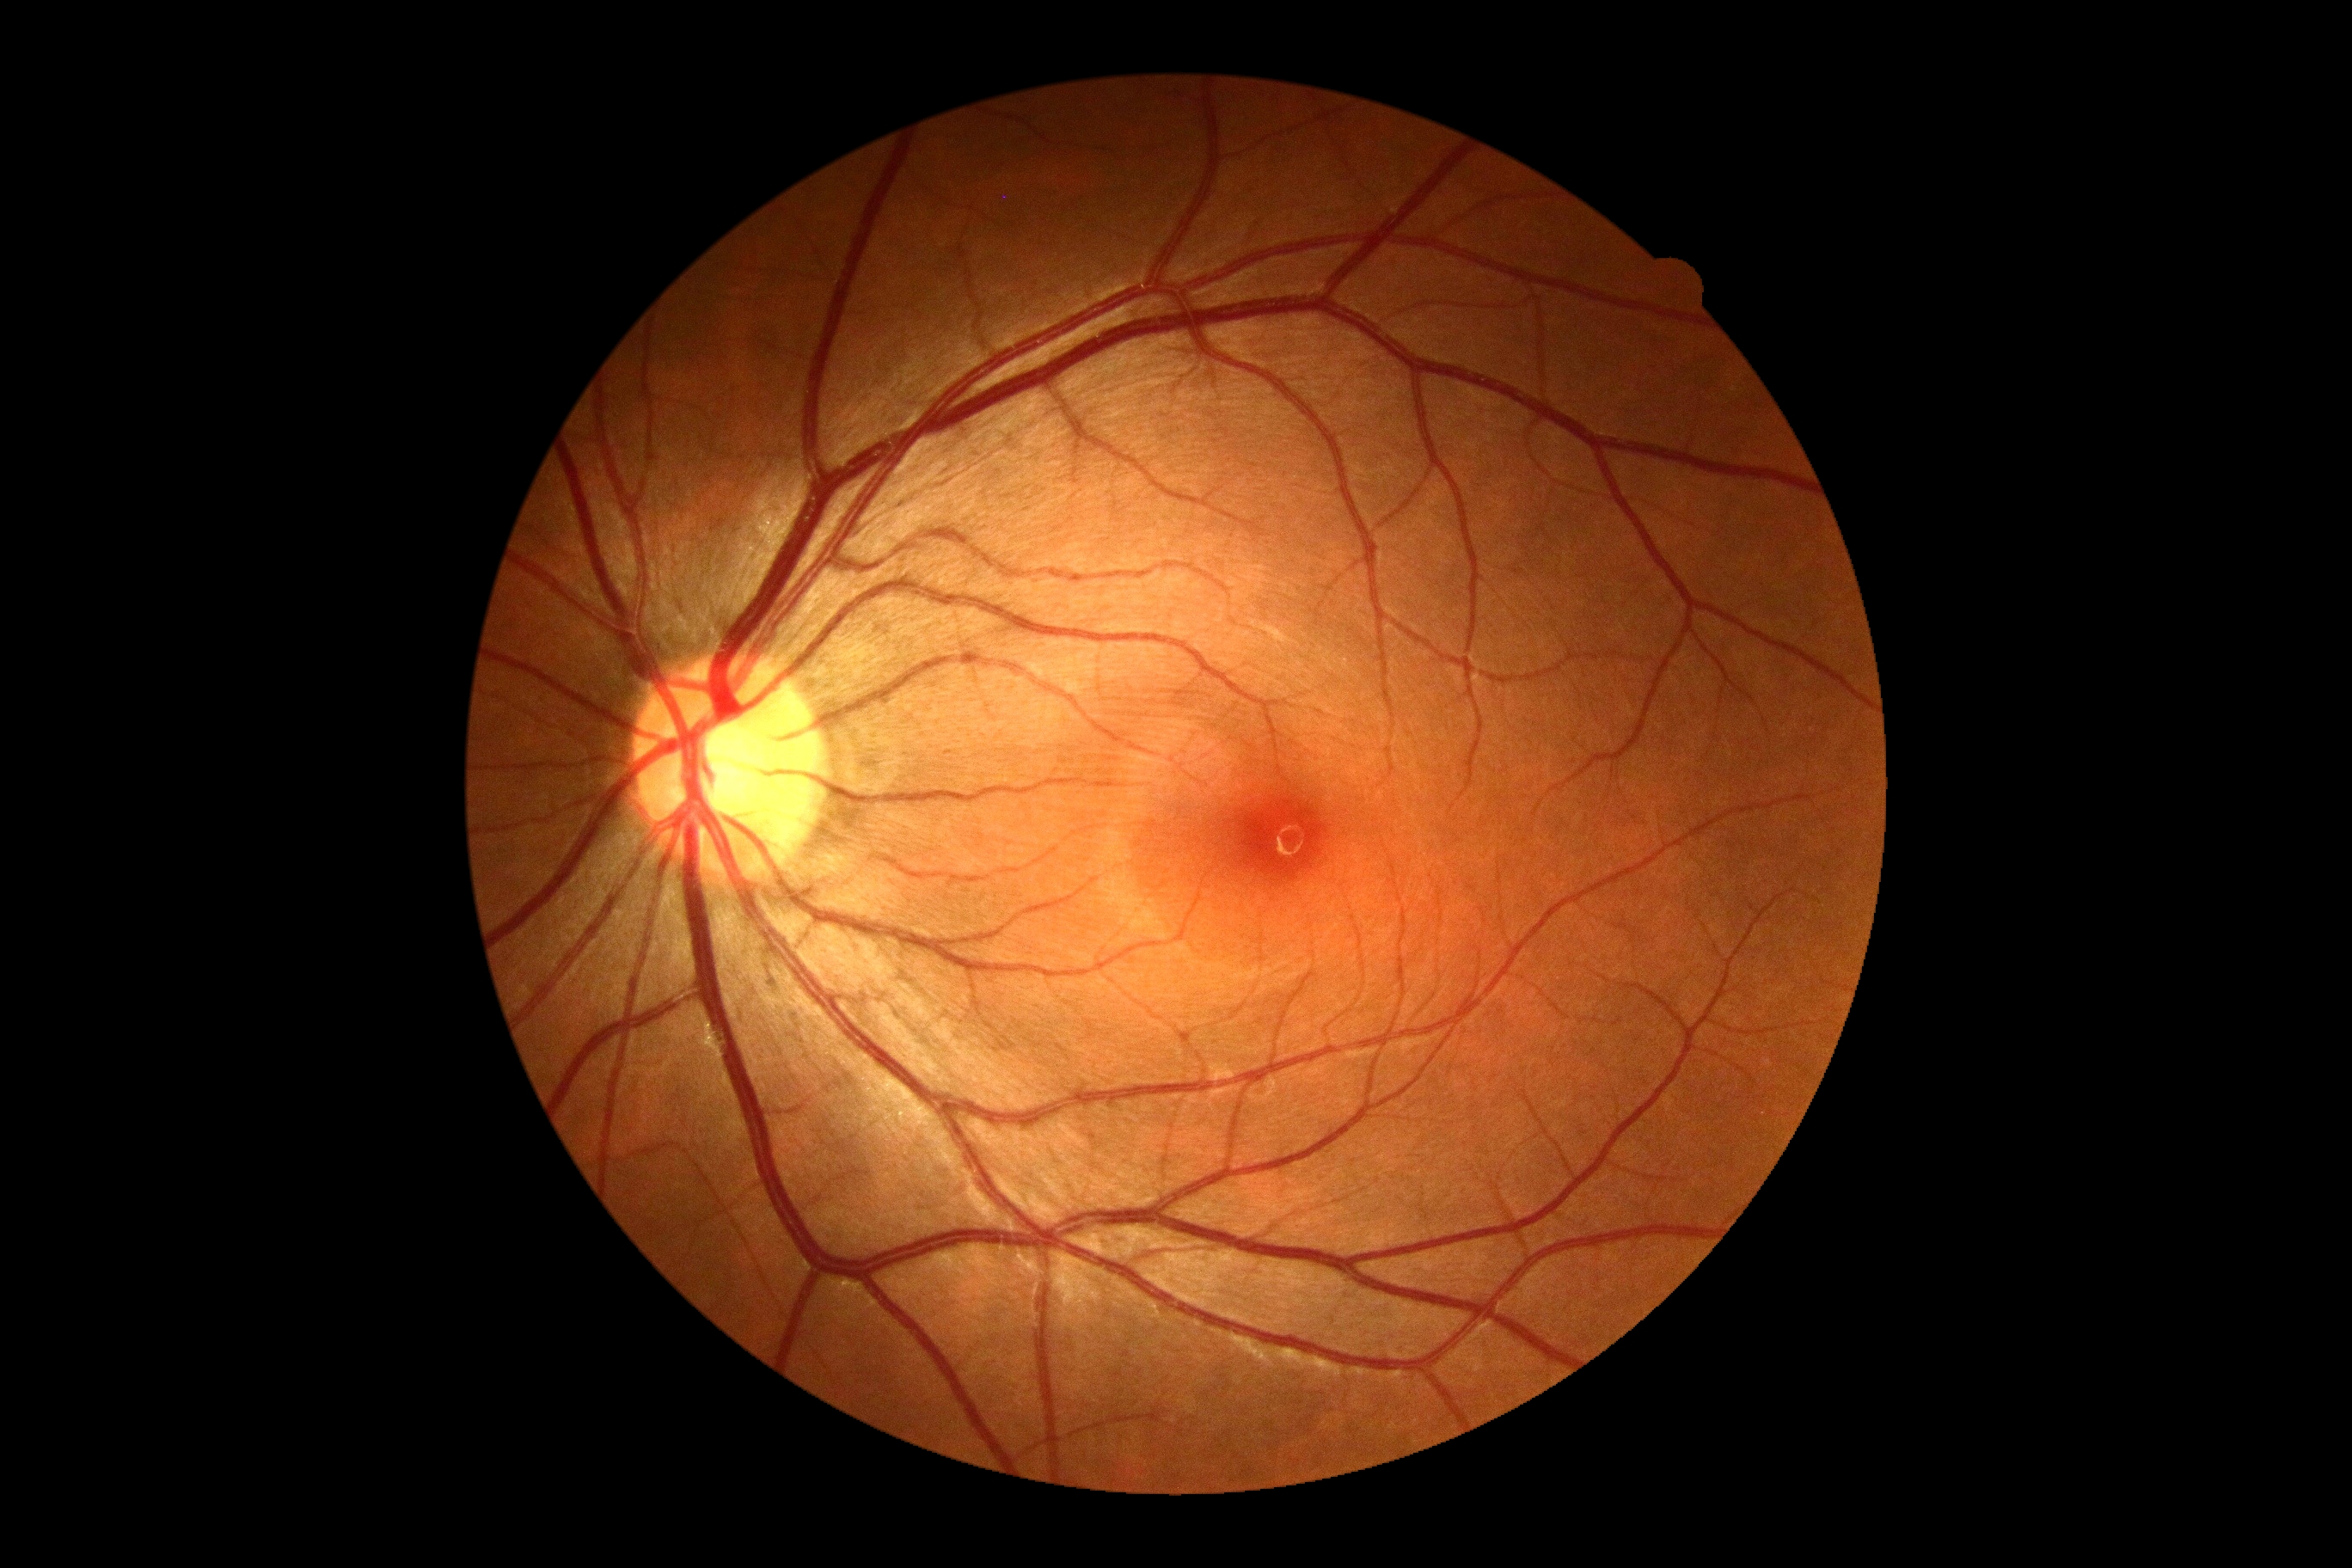 No DR findings. Diabetic retinopathy is grade 0 (no apparent retinopathy) — no visible signs of diabetic retinopathy.